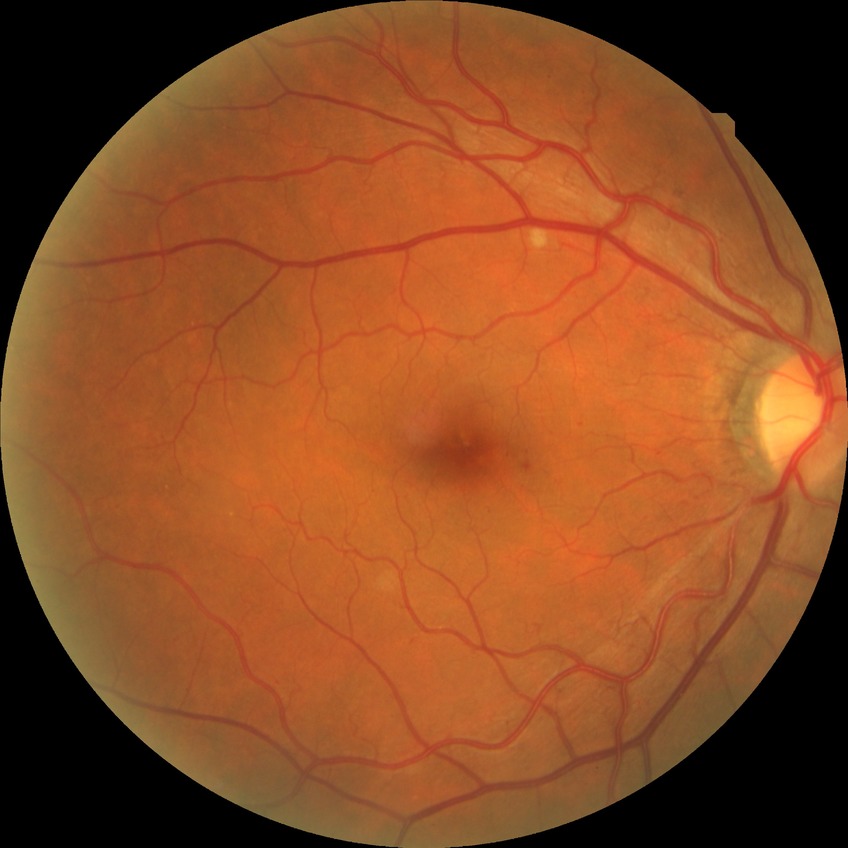   davis_grade: simple diabetic retinopathy